2212x1672px, 45-degree field of view, fundus photo
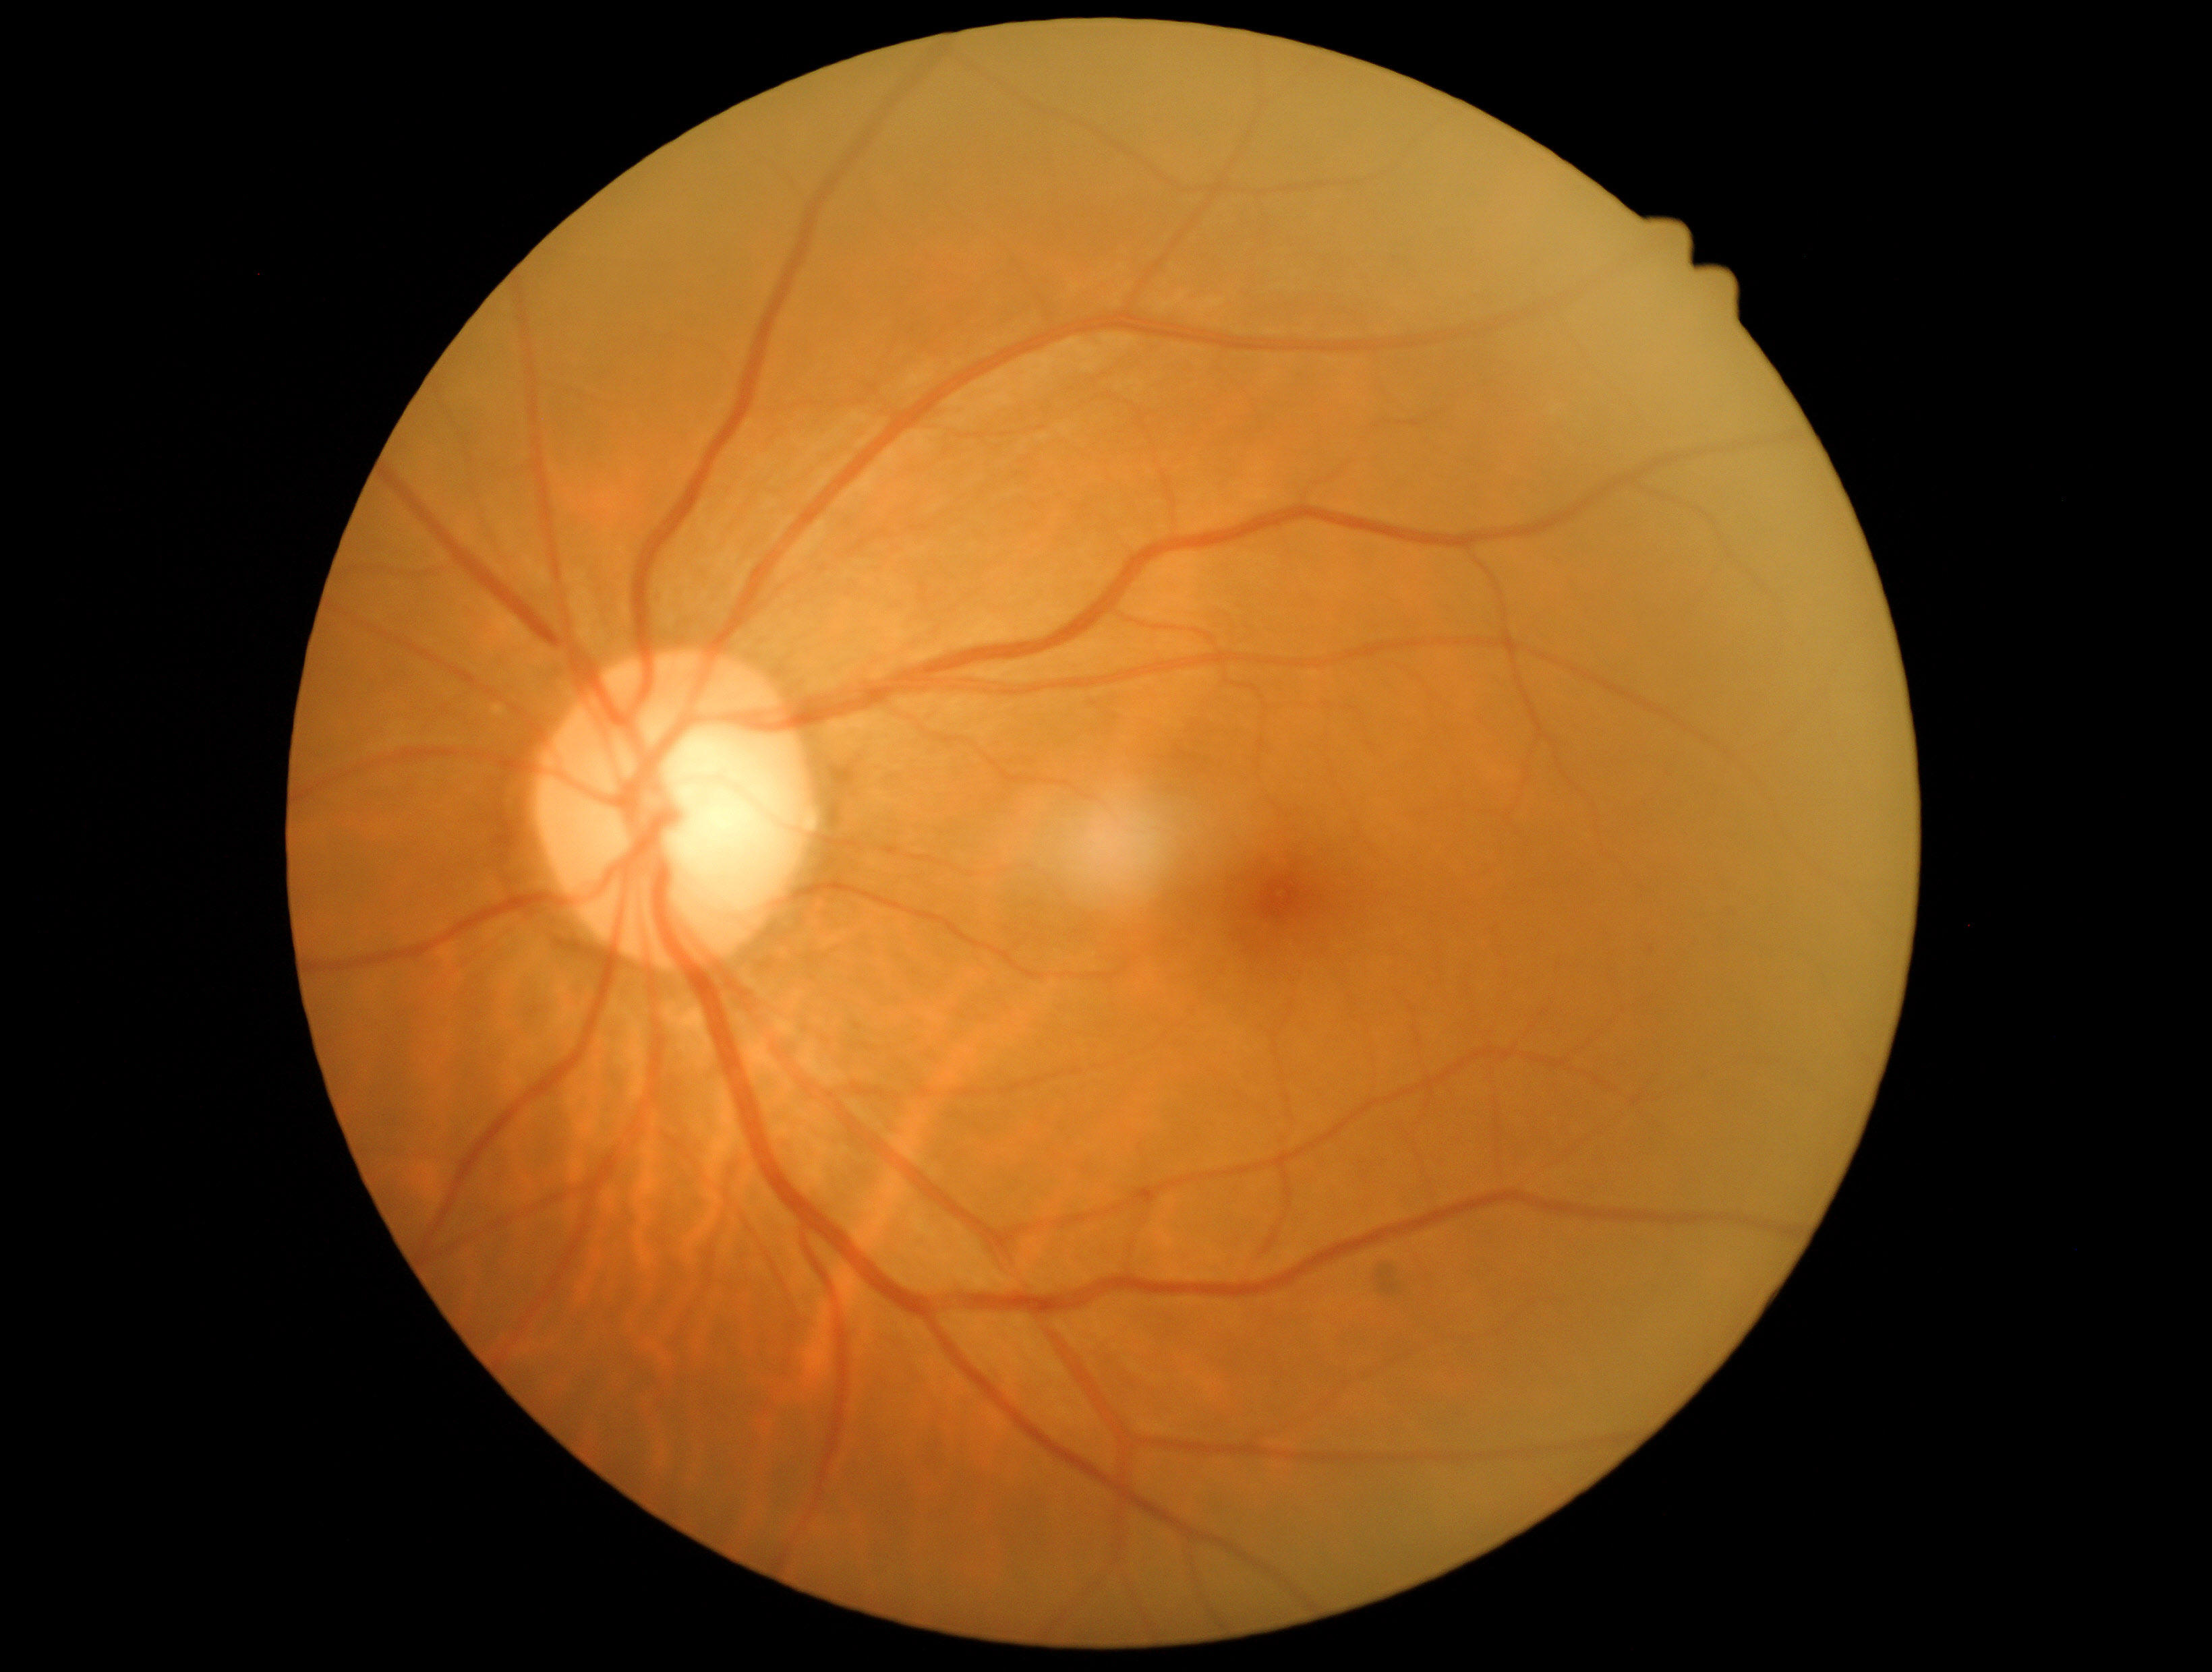

DR is grade 0.